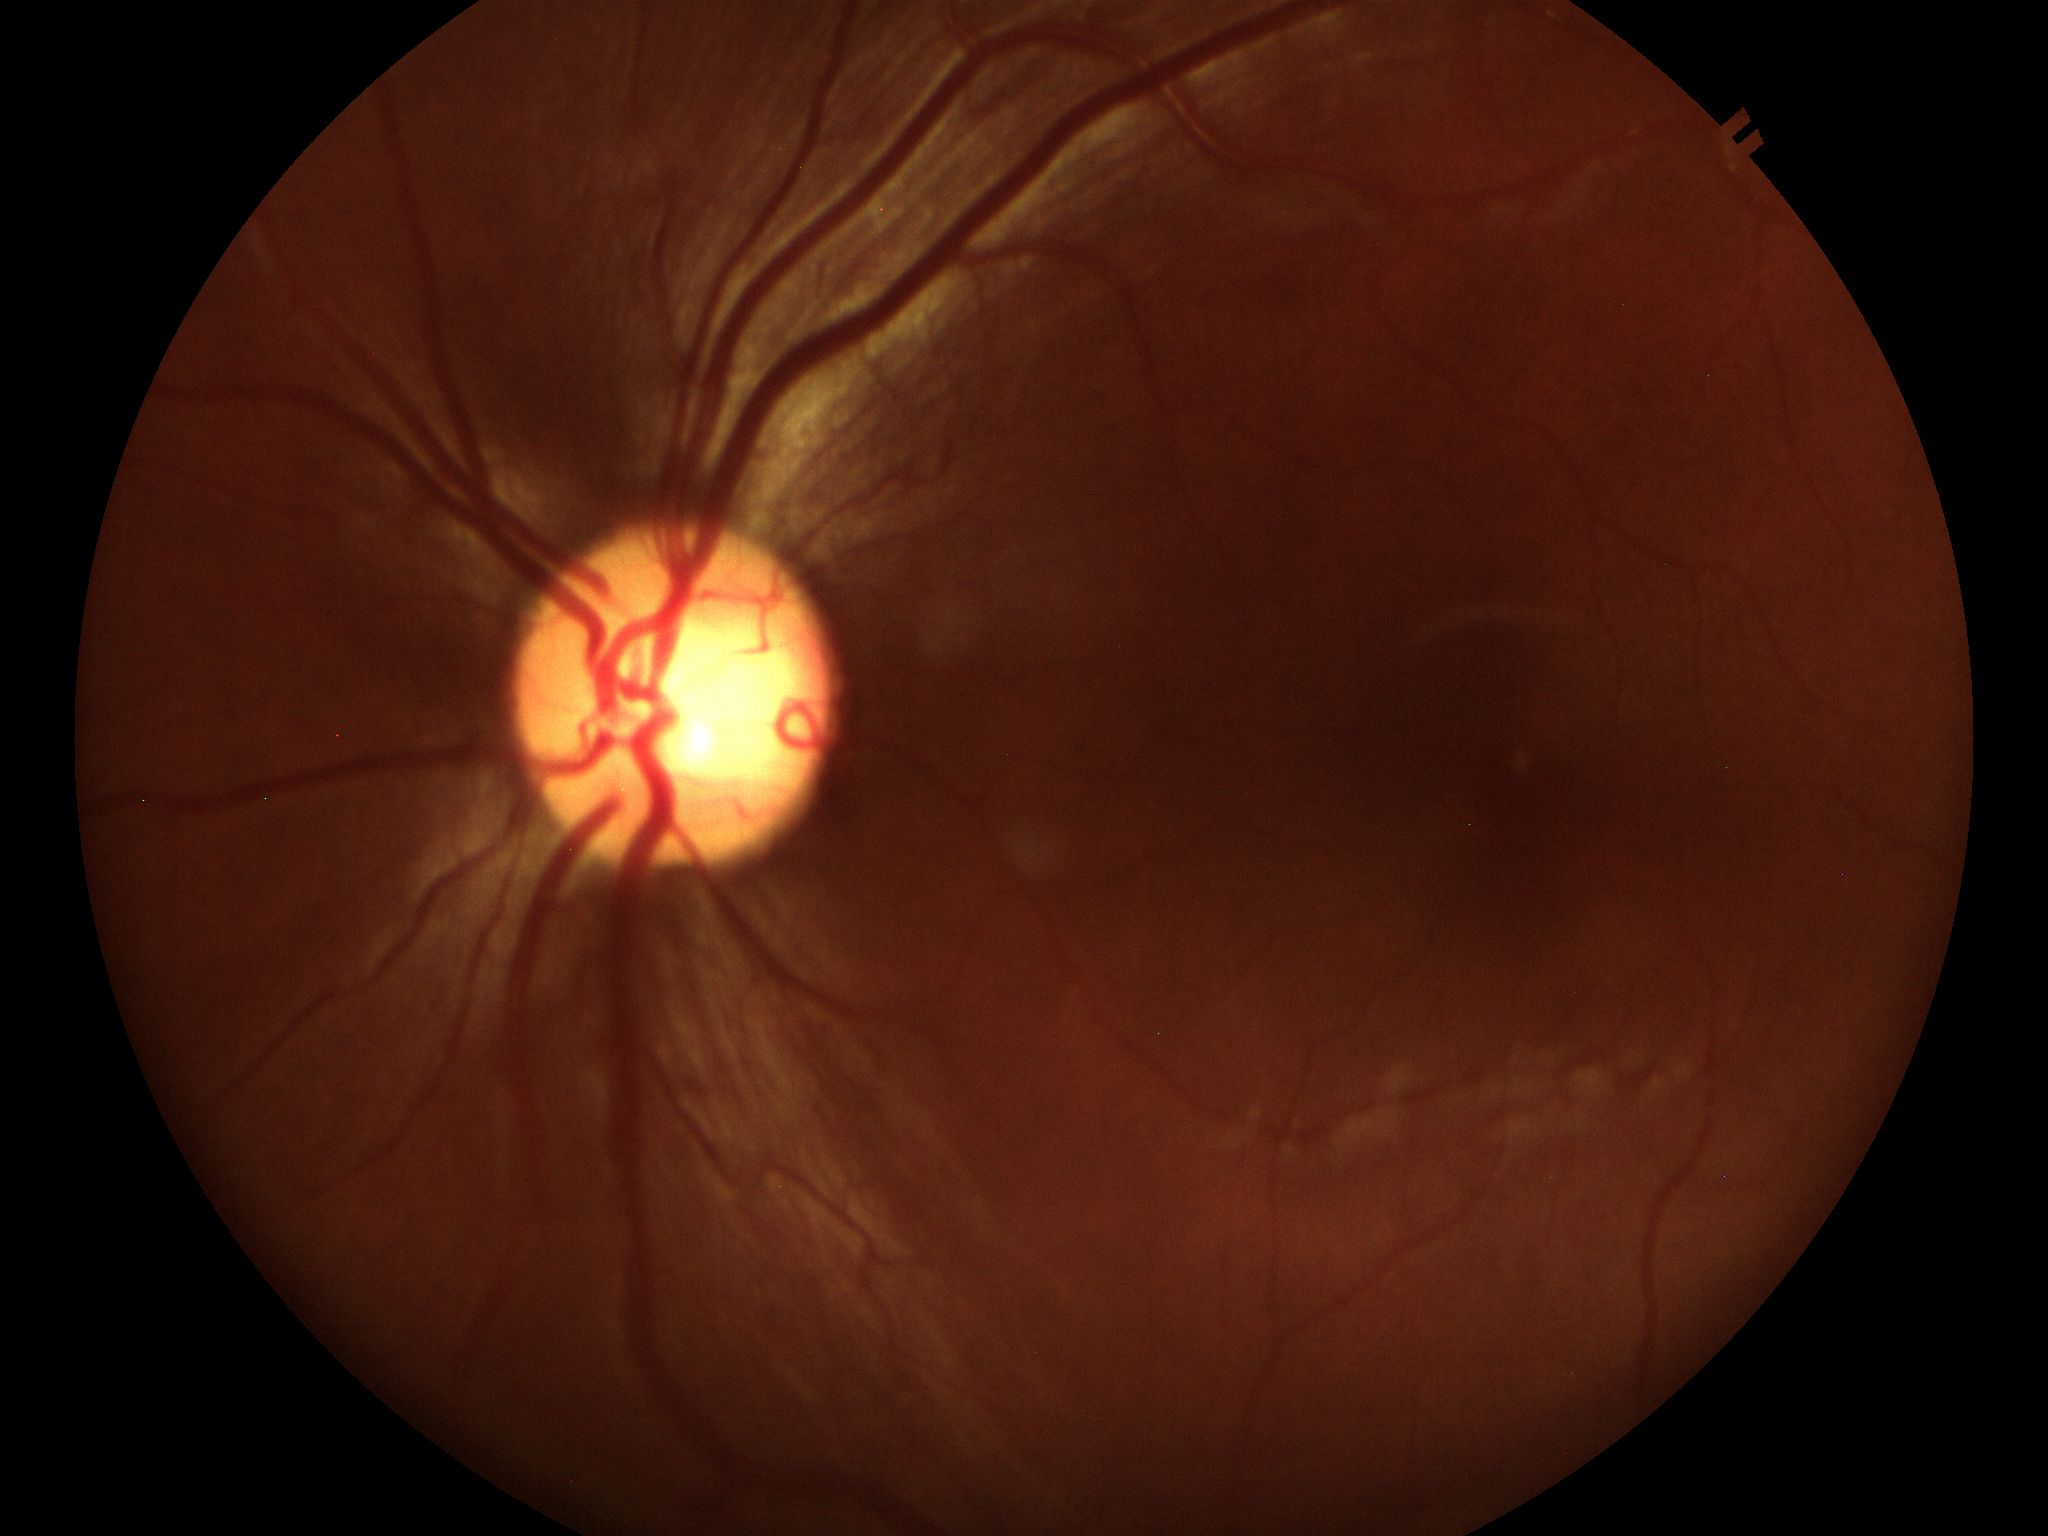

VCDR: 0.53. Not suspicious for glaucoma.